Wide-field fundus photograph from neonatal ROP screening. Clarity RetCam 3, 130° FOV
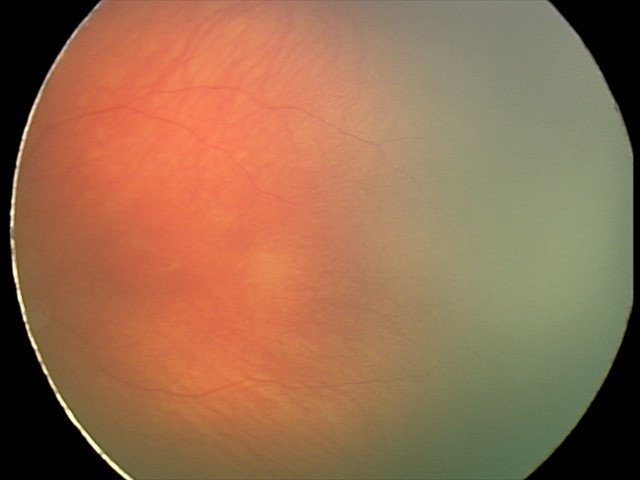

Examination with physiological retinal findings.